2212x1659px
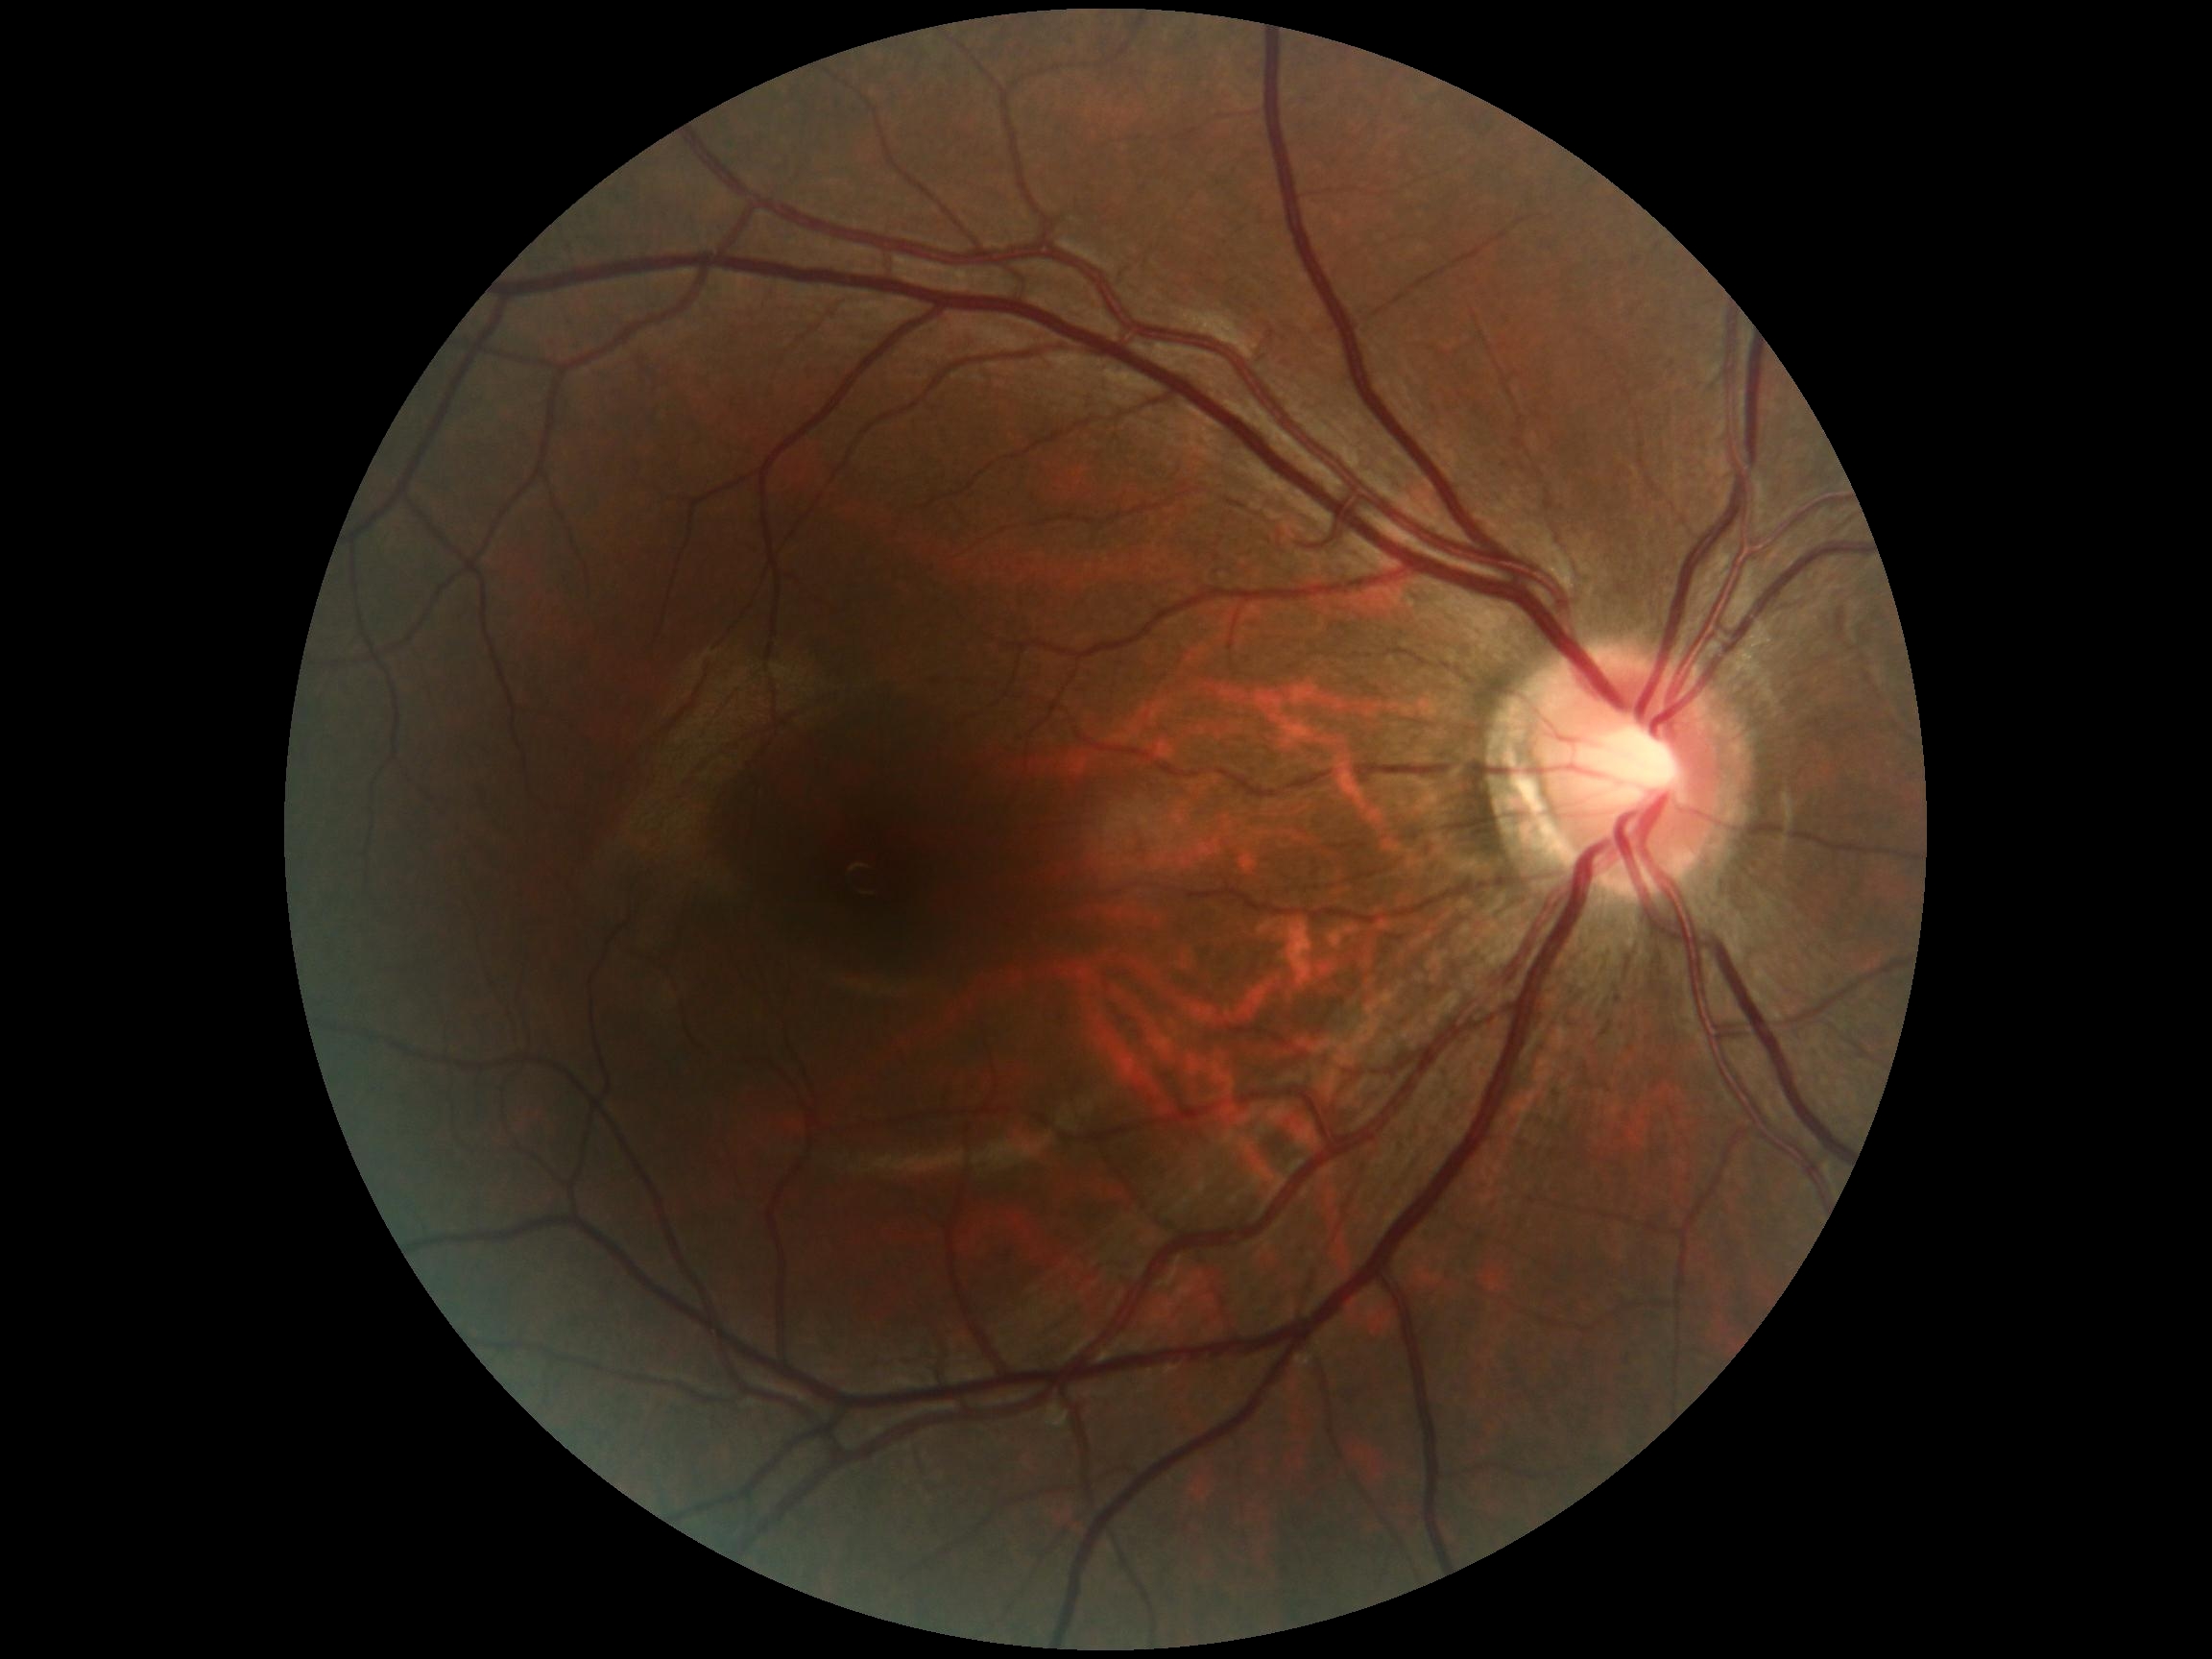 No diabetic retinal disease findings. Retinopathy is grade 0 (no apparent retinopathy).